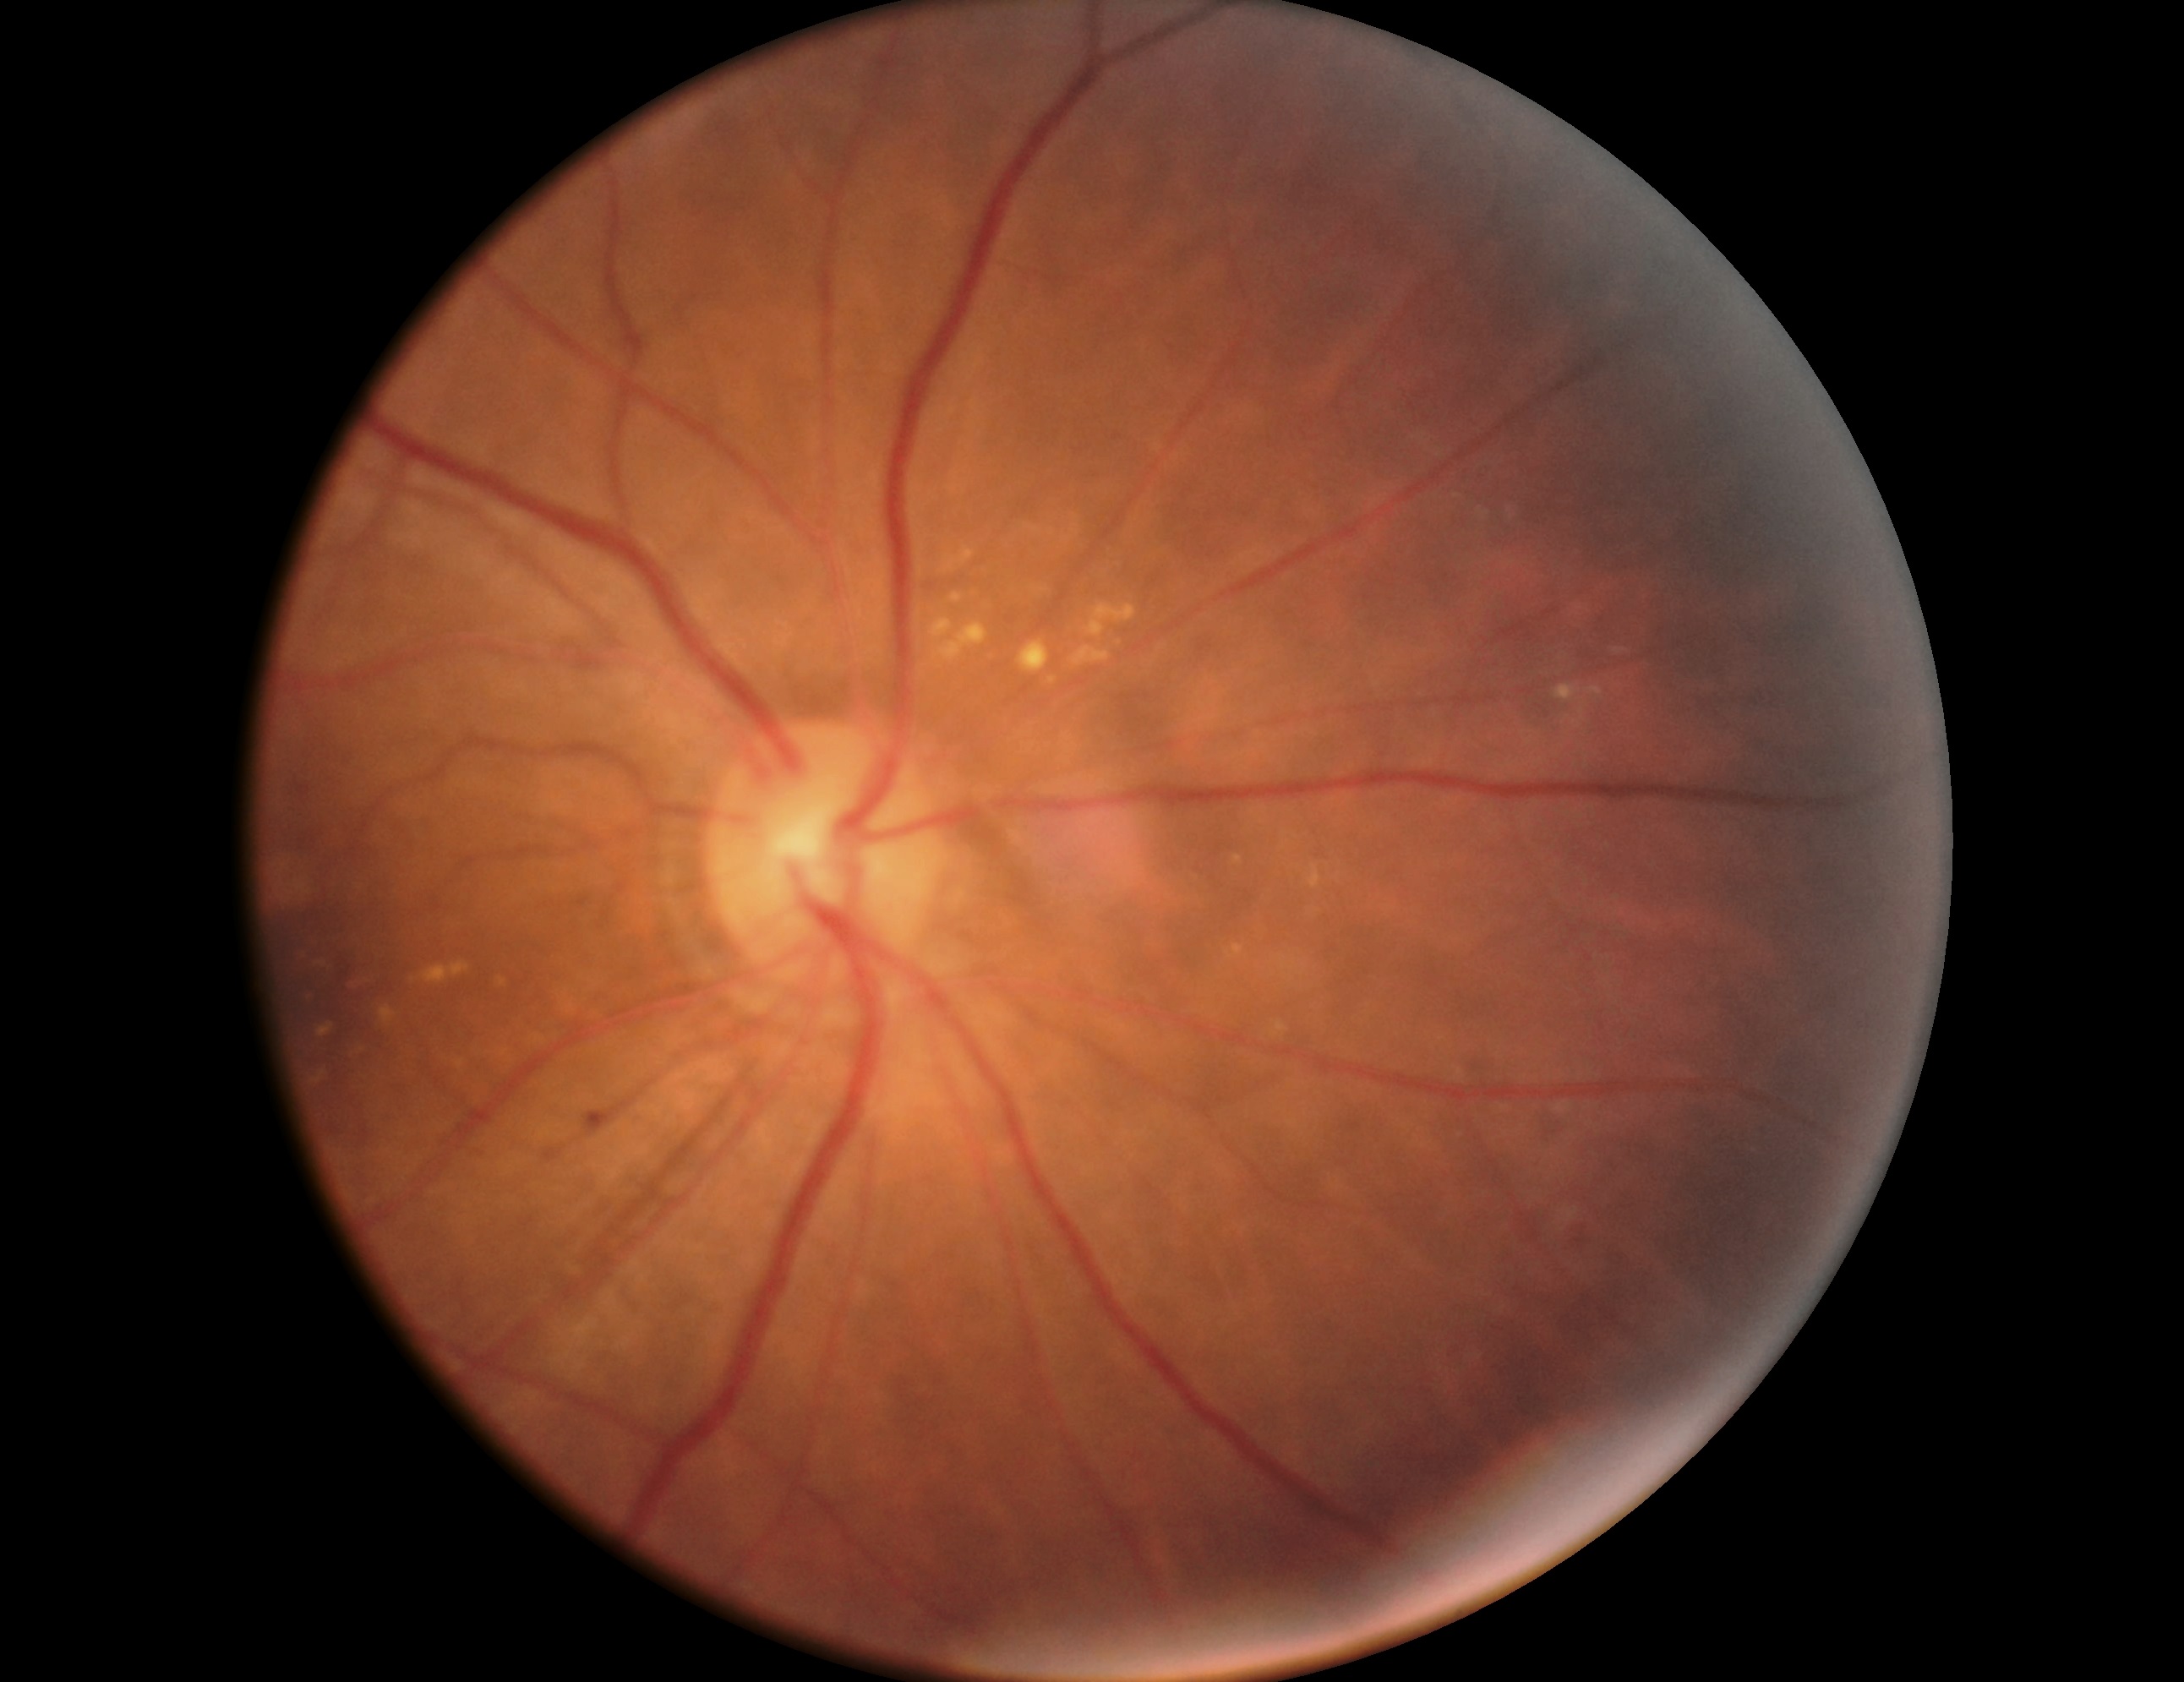
Annotations:
– retinopathy grade — moderate NPDR (2) — more than just microaneurysms but less than severe NPDR